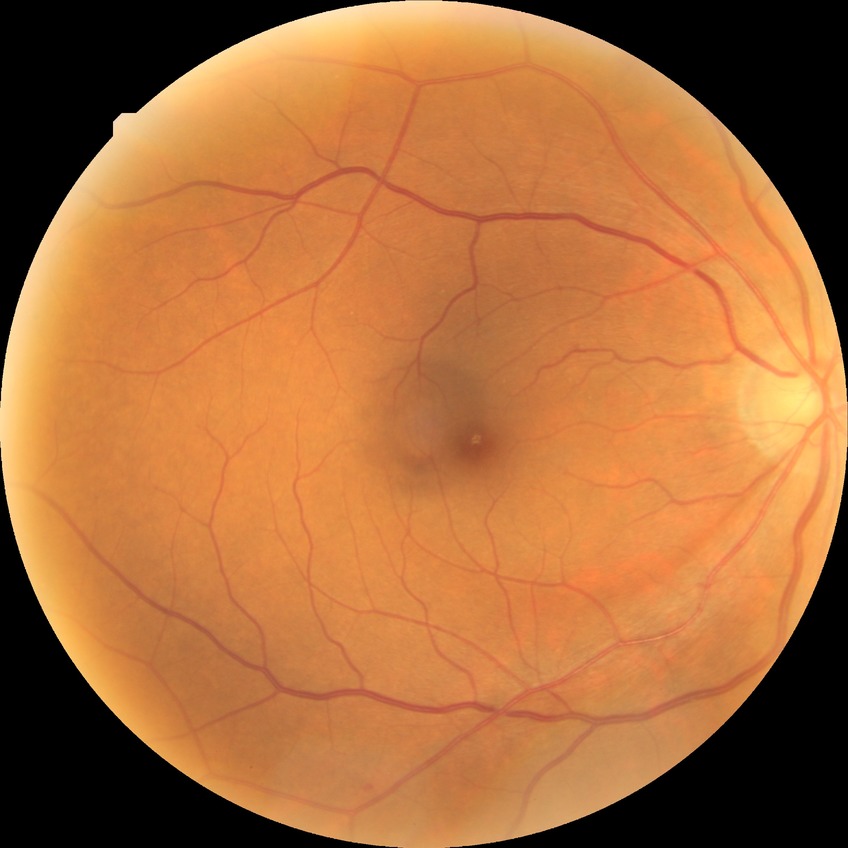
diabetic retinopathy (DR): NDR (no diabetic retinopathy).